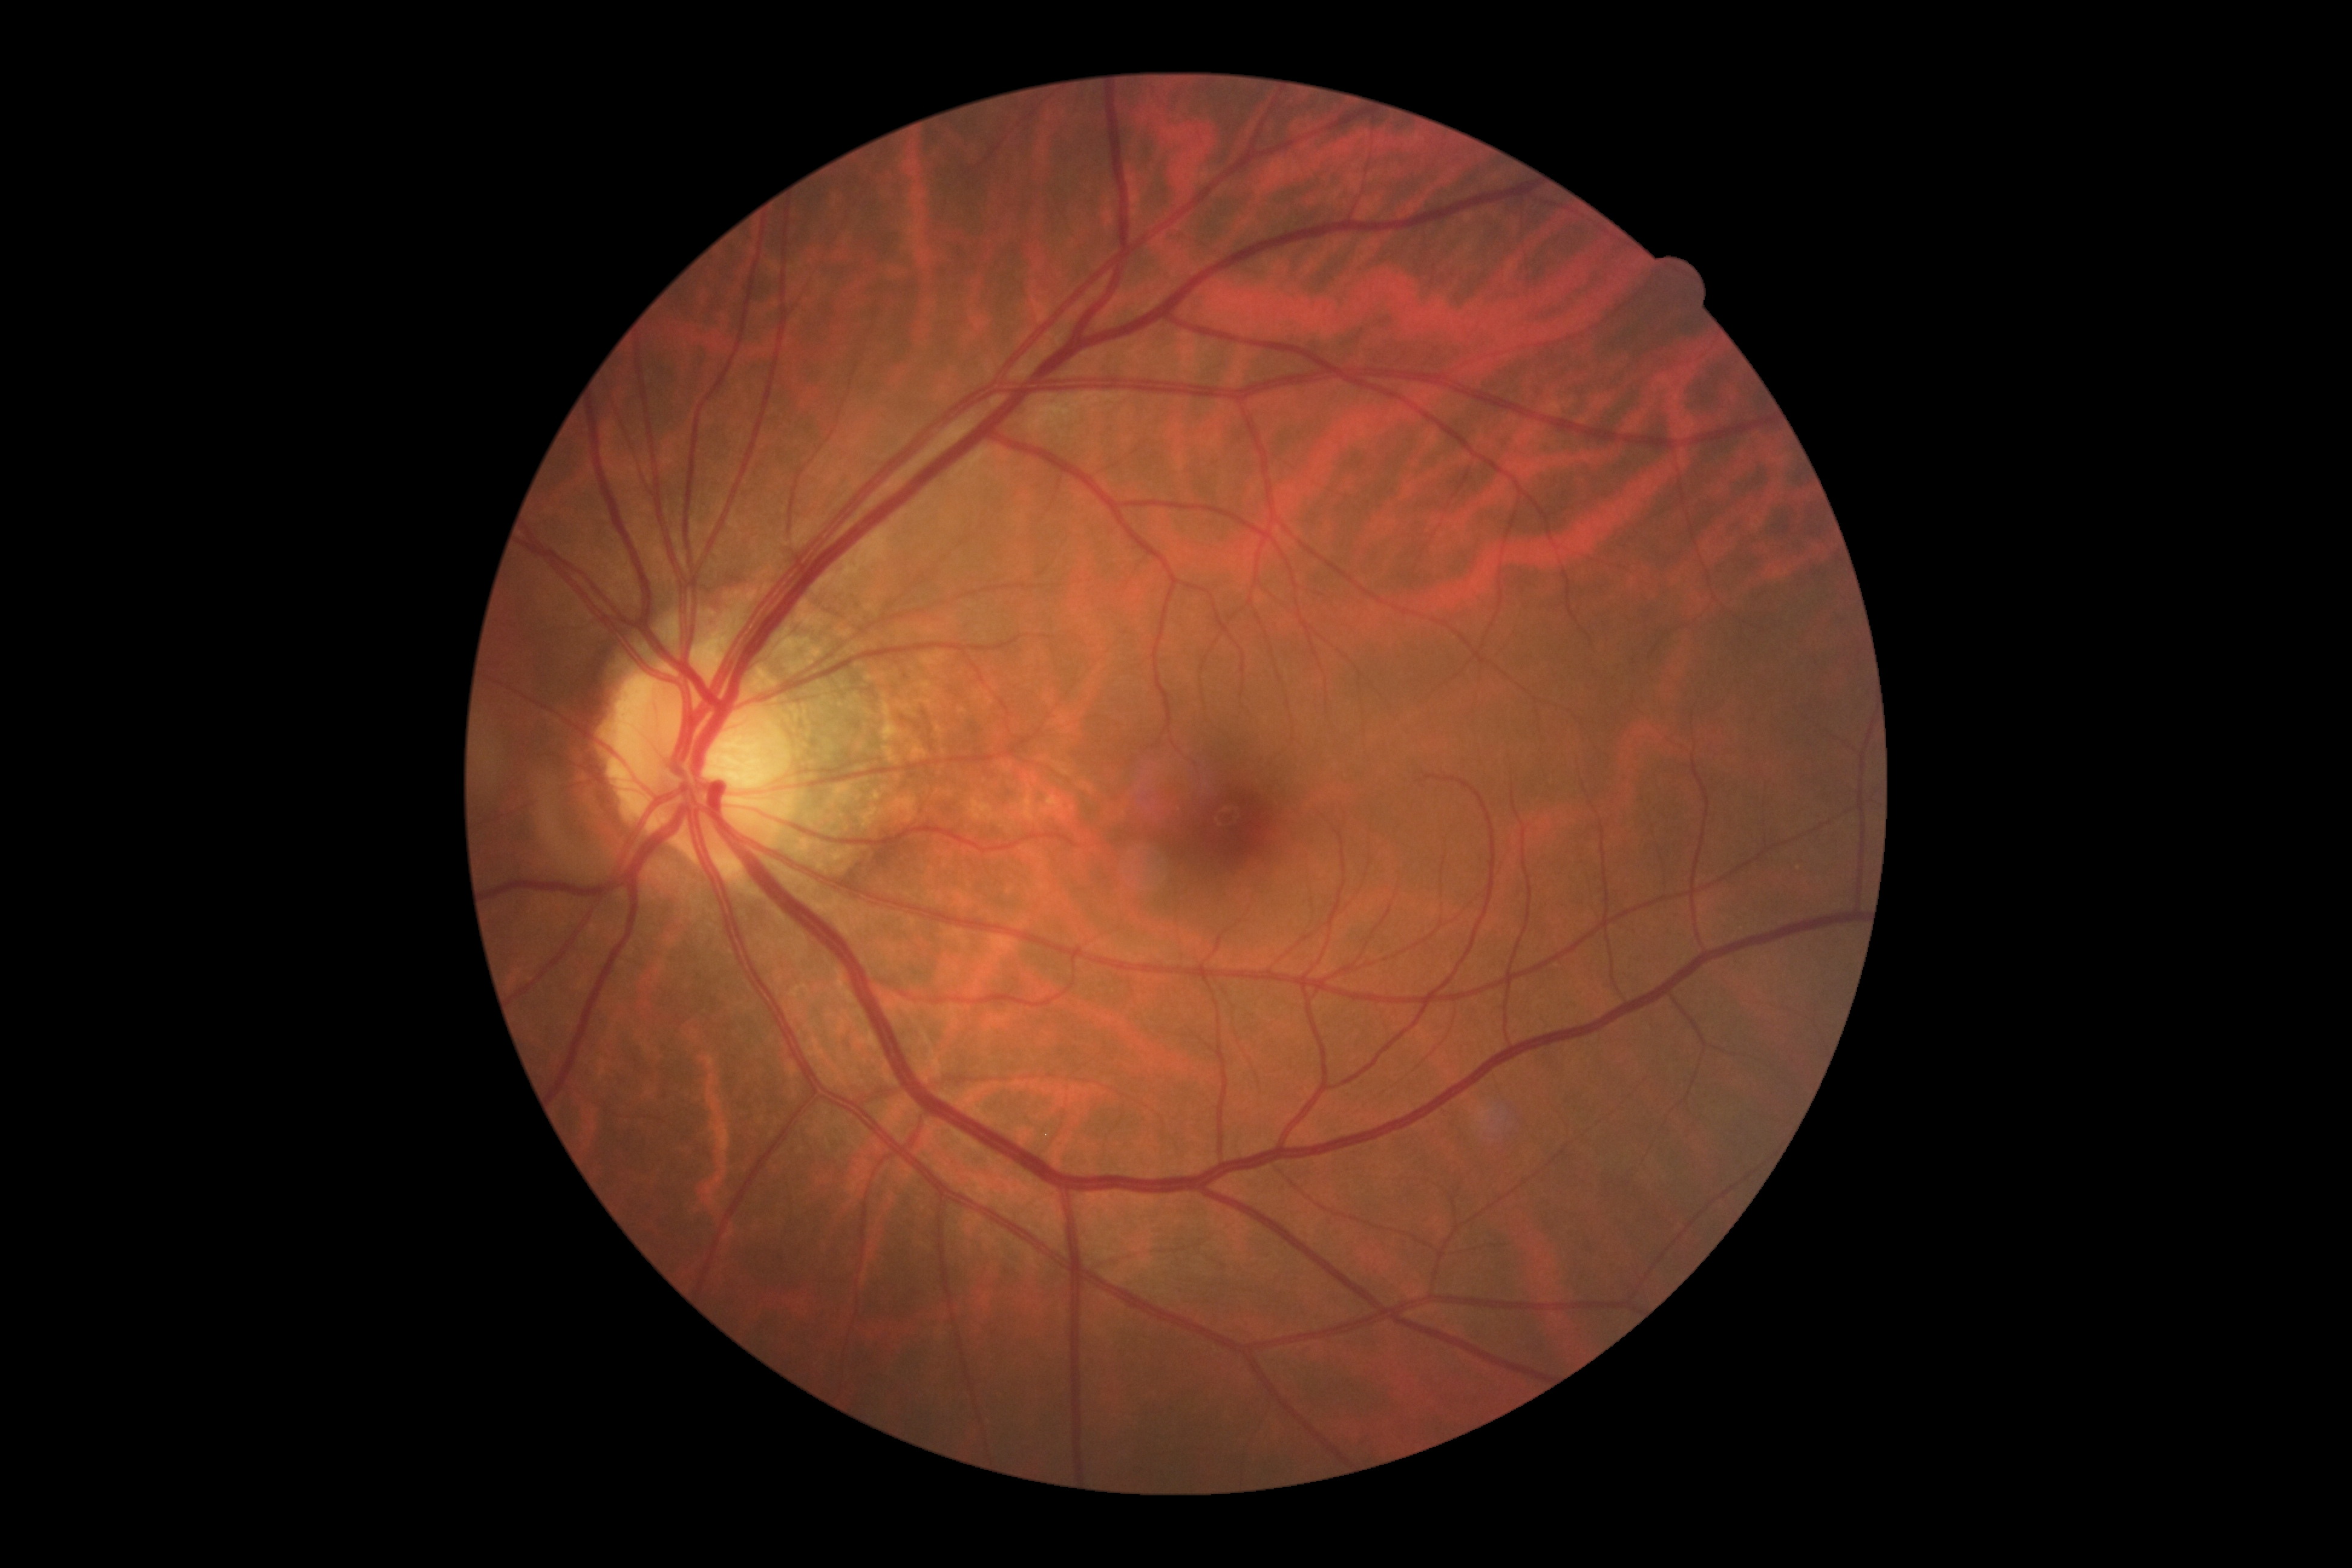
DR is no apparent retinopathy (grade 0).